Posterior pole color fundus photograph, 45° field of view, nonmydriatic, graded on the modified Davis scale — 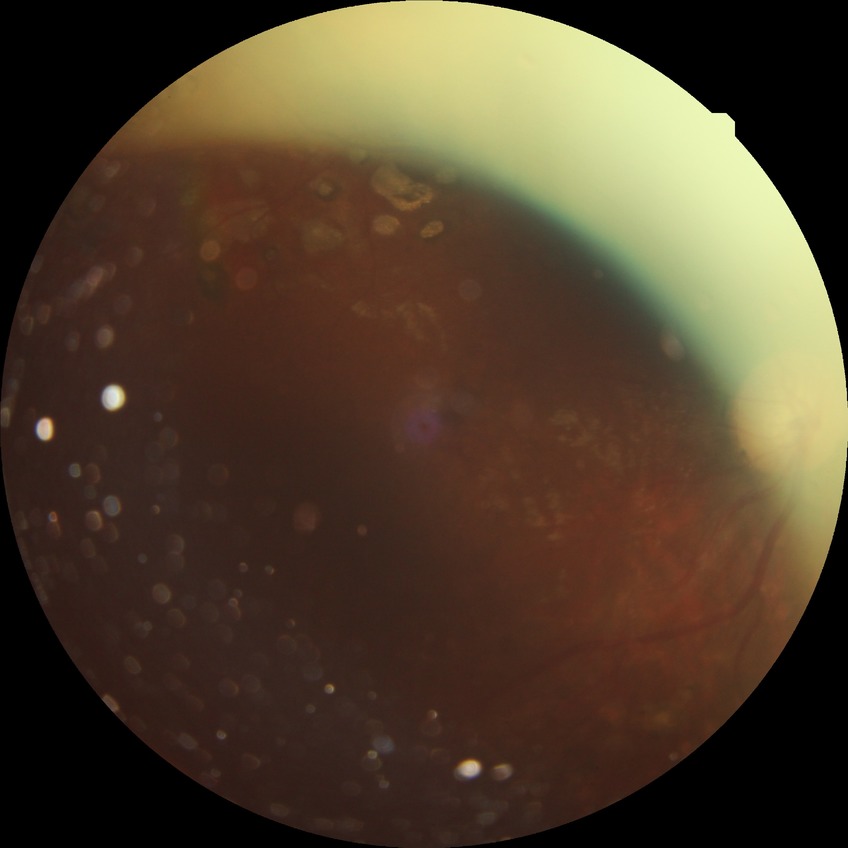

Annotations:
– diabetic retinopathy (DR): PDR (proliferative diabetic retinopathy)